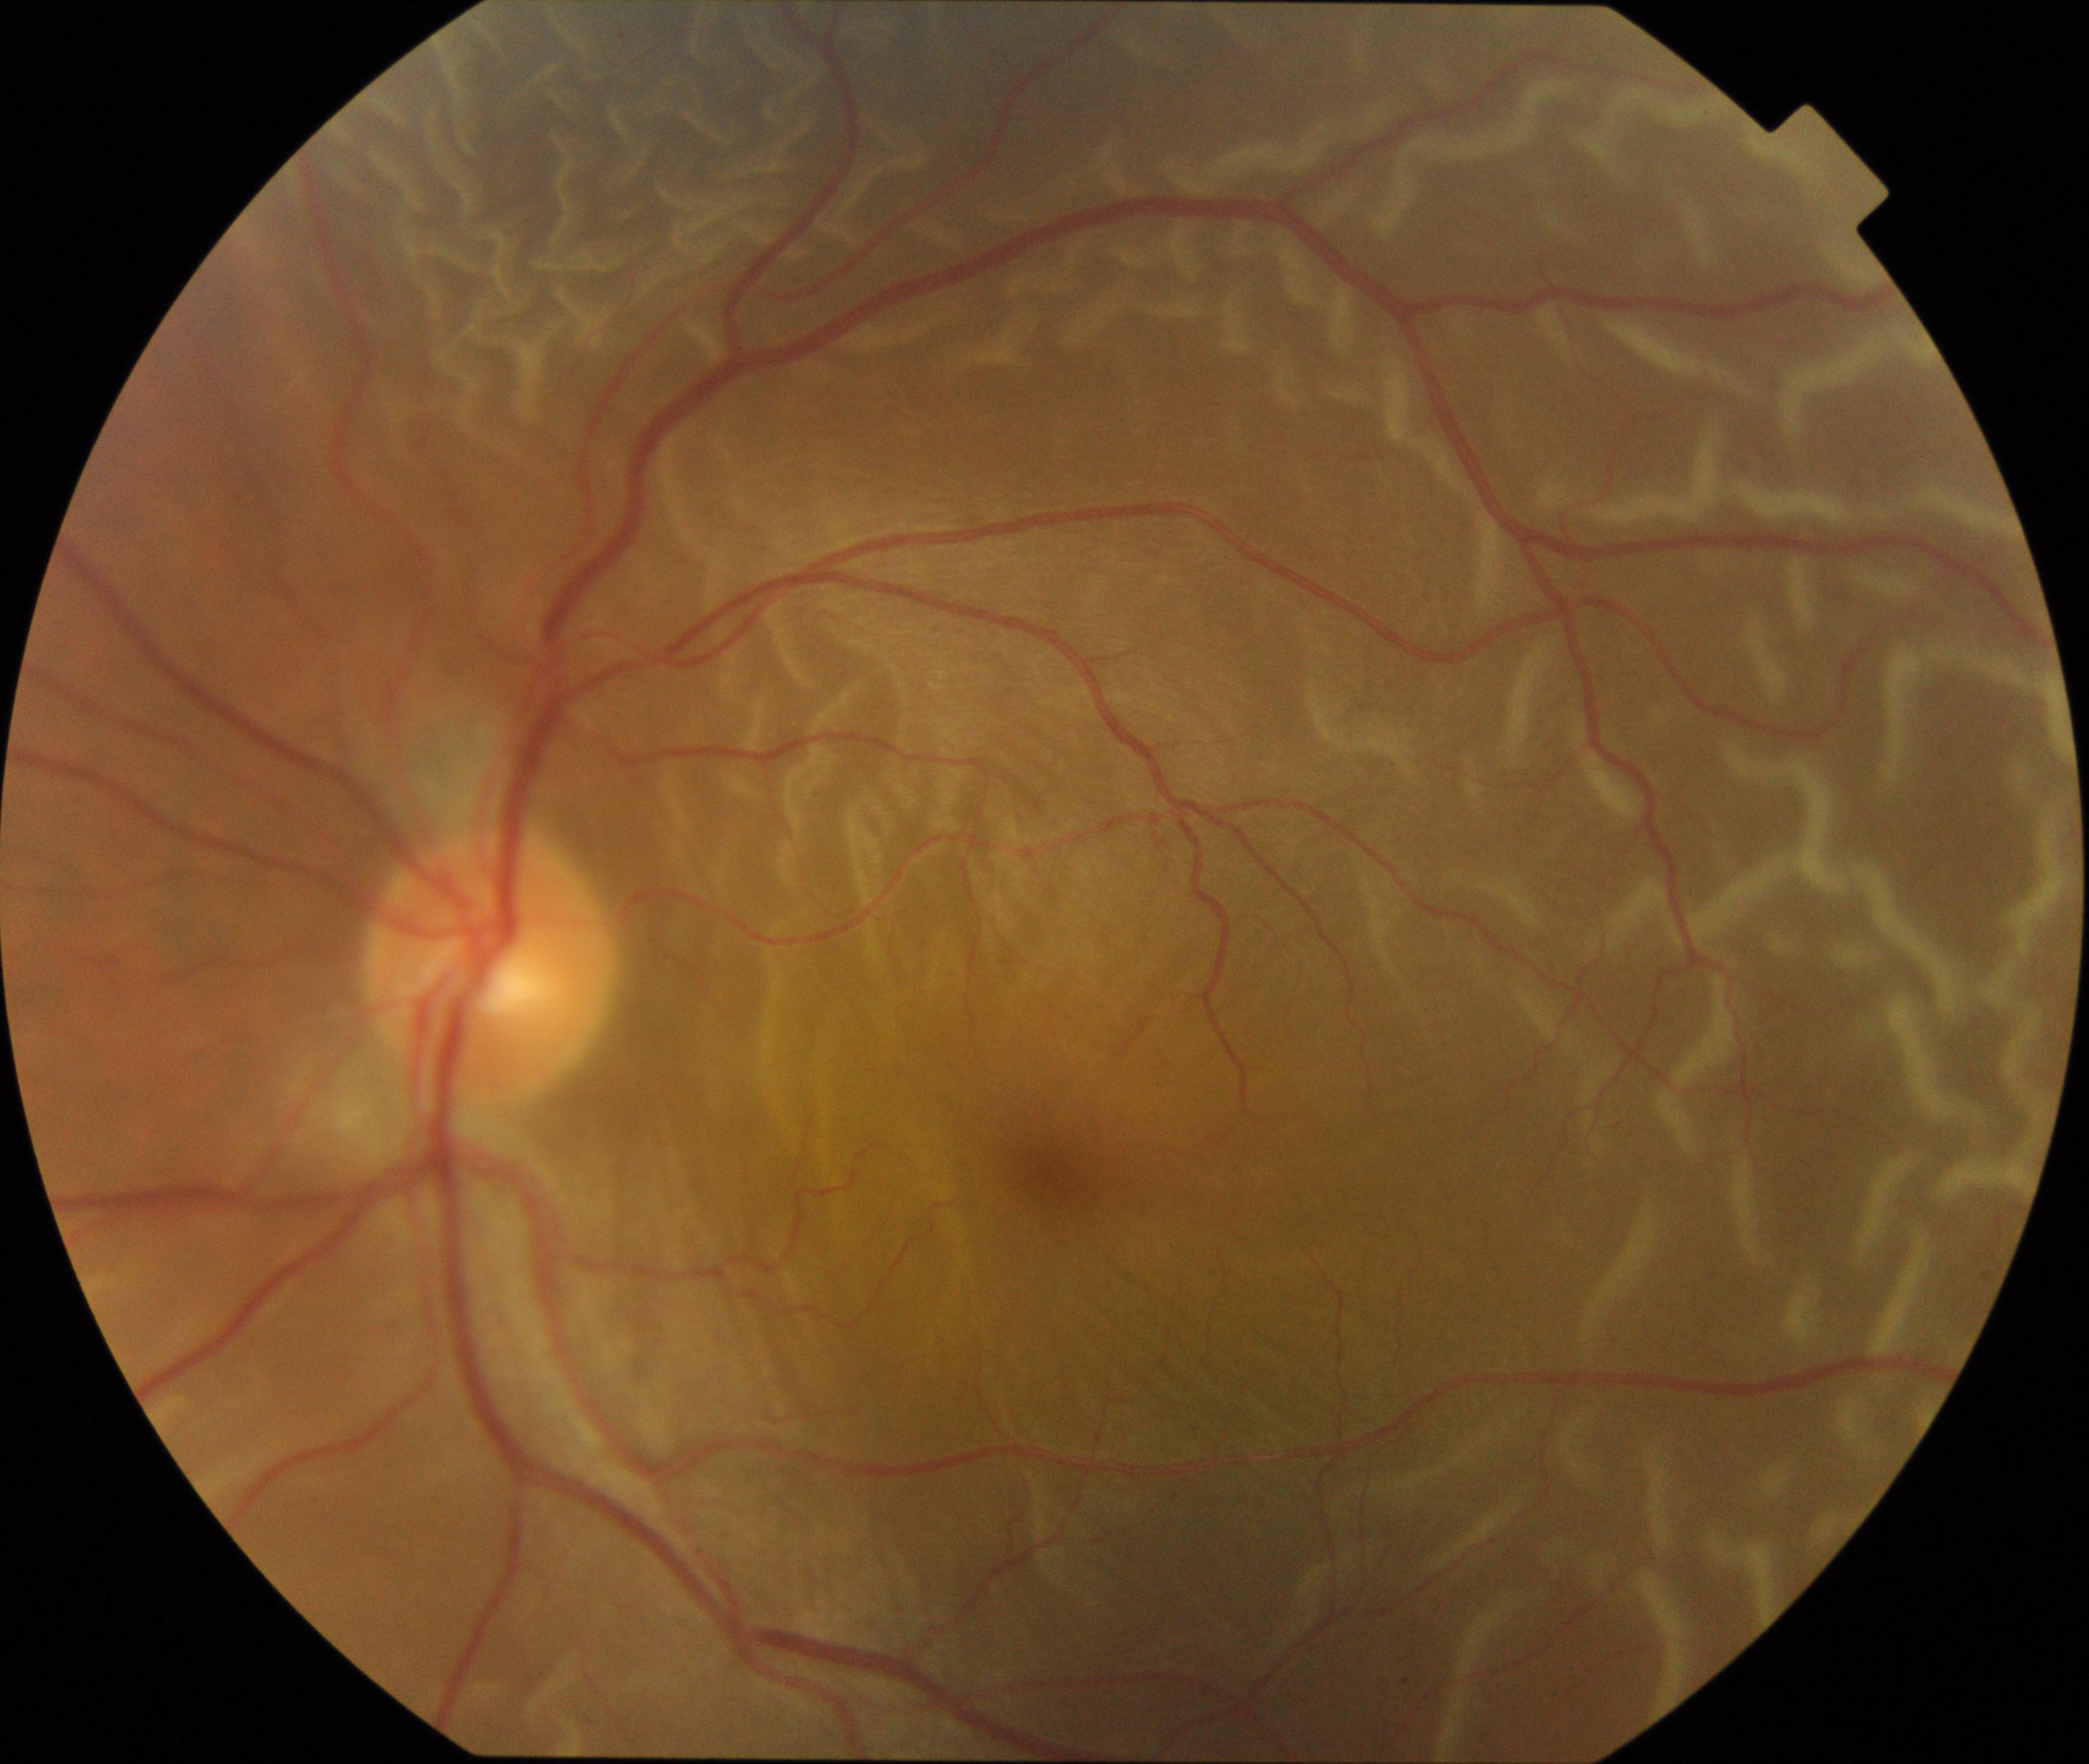 Fundus appearance consistent with rhegmatogenous retinal detachment.